Fundus photo — 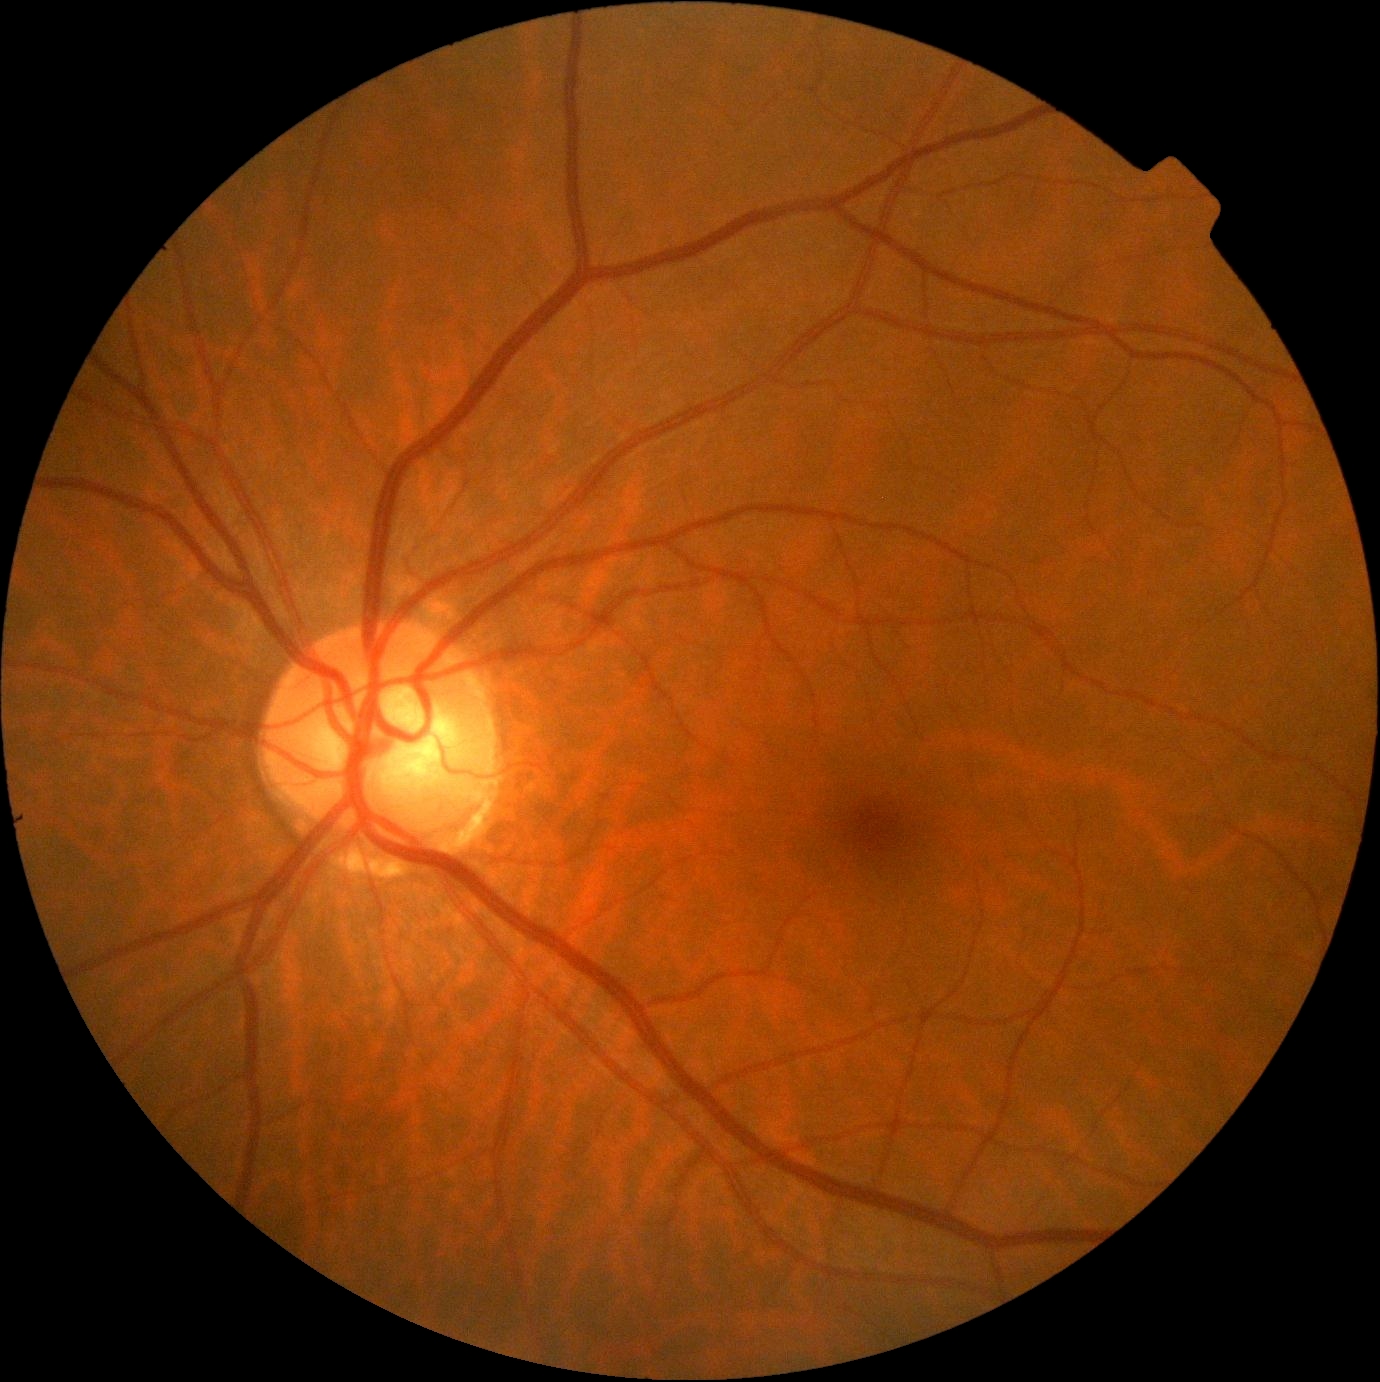
DR severity is grade 0 (no apparent retinopathy).